2352x1568
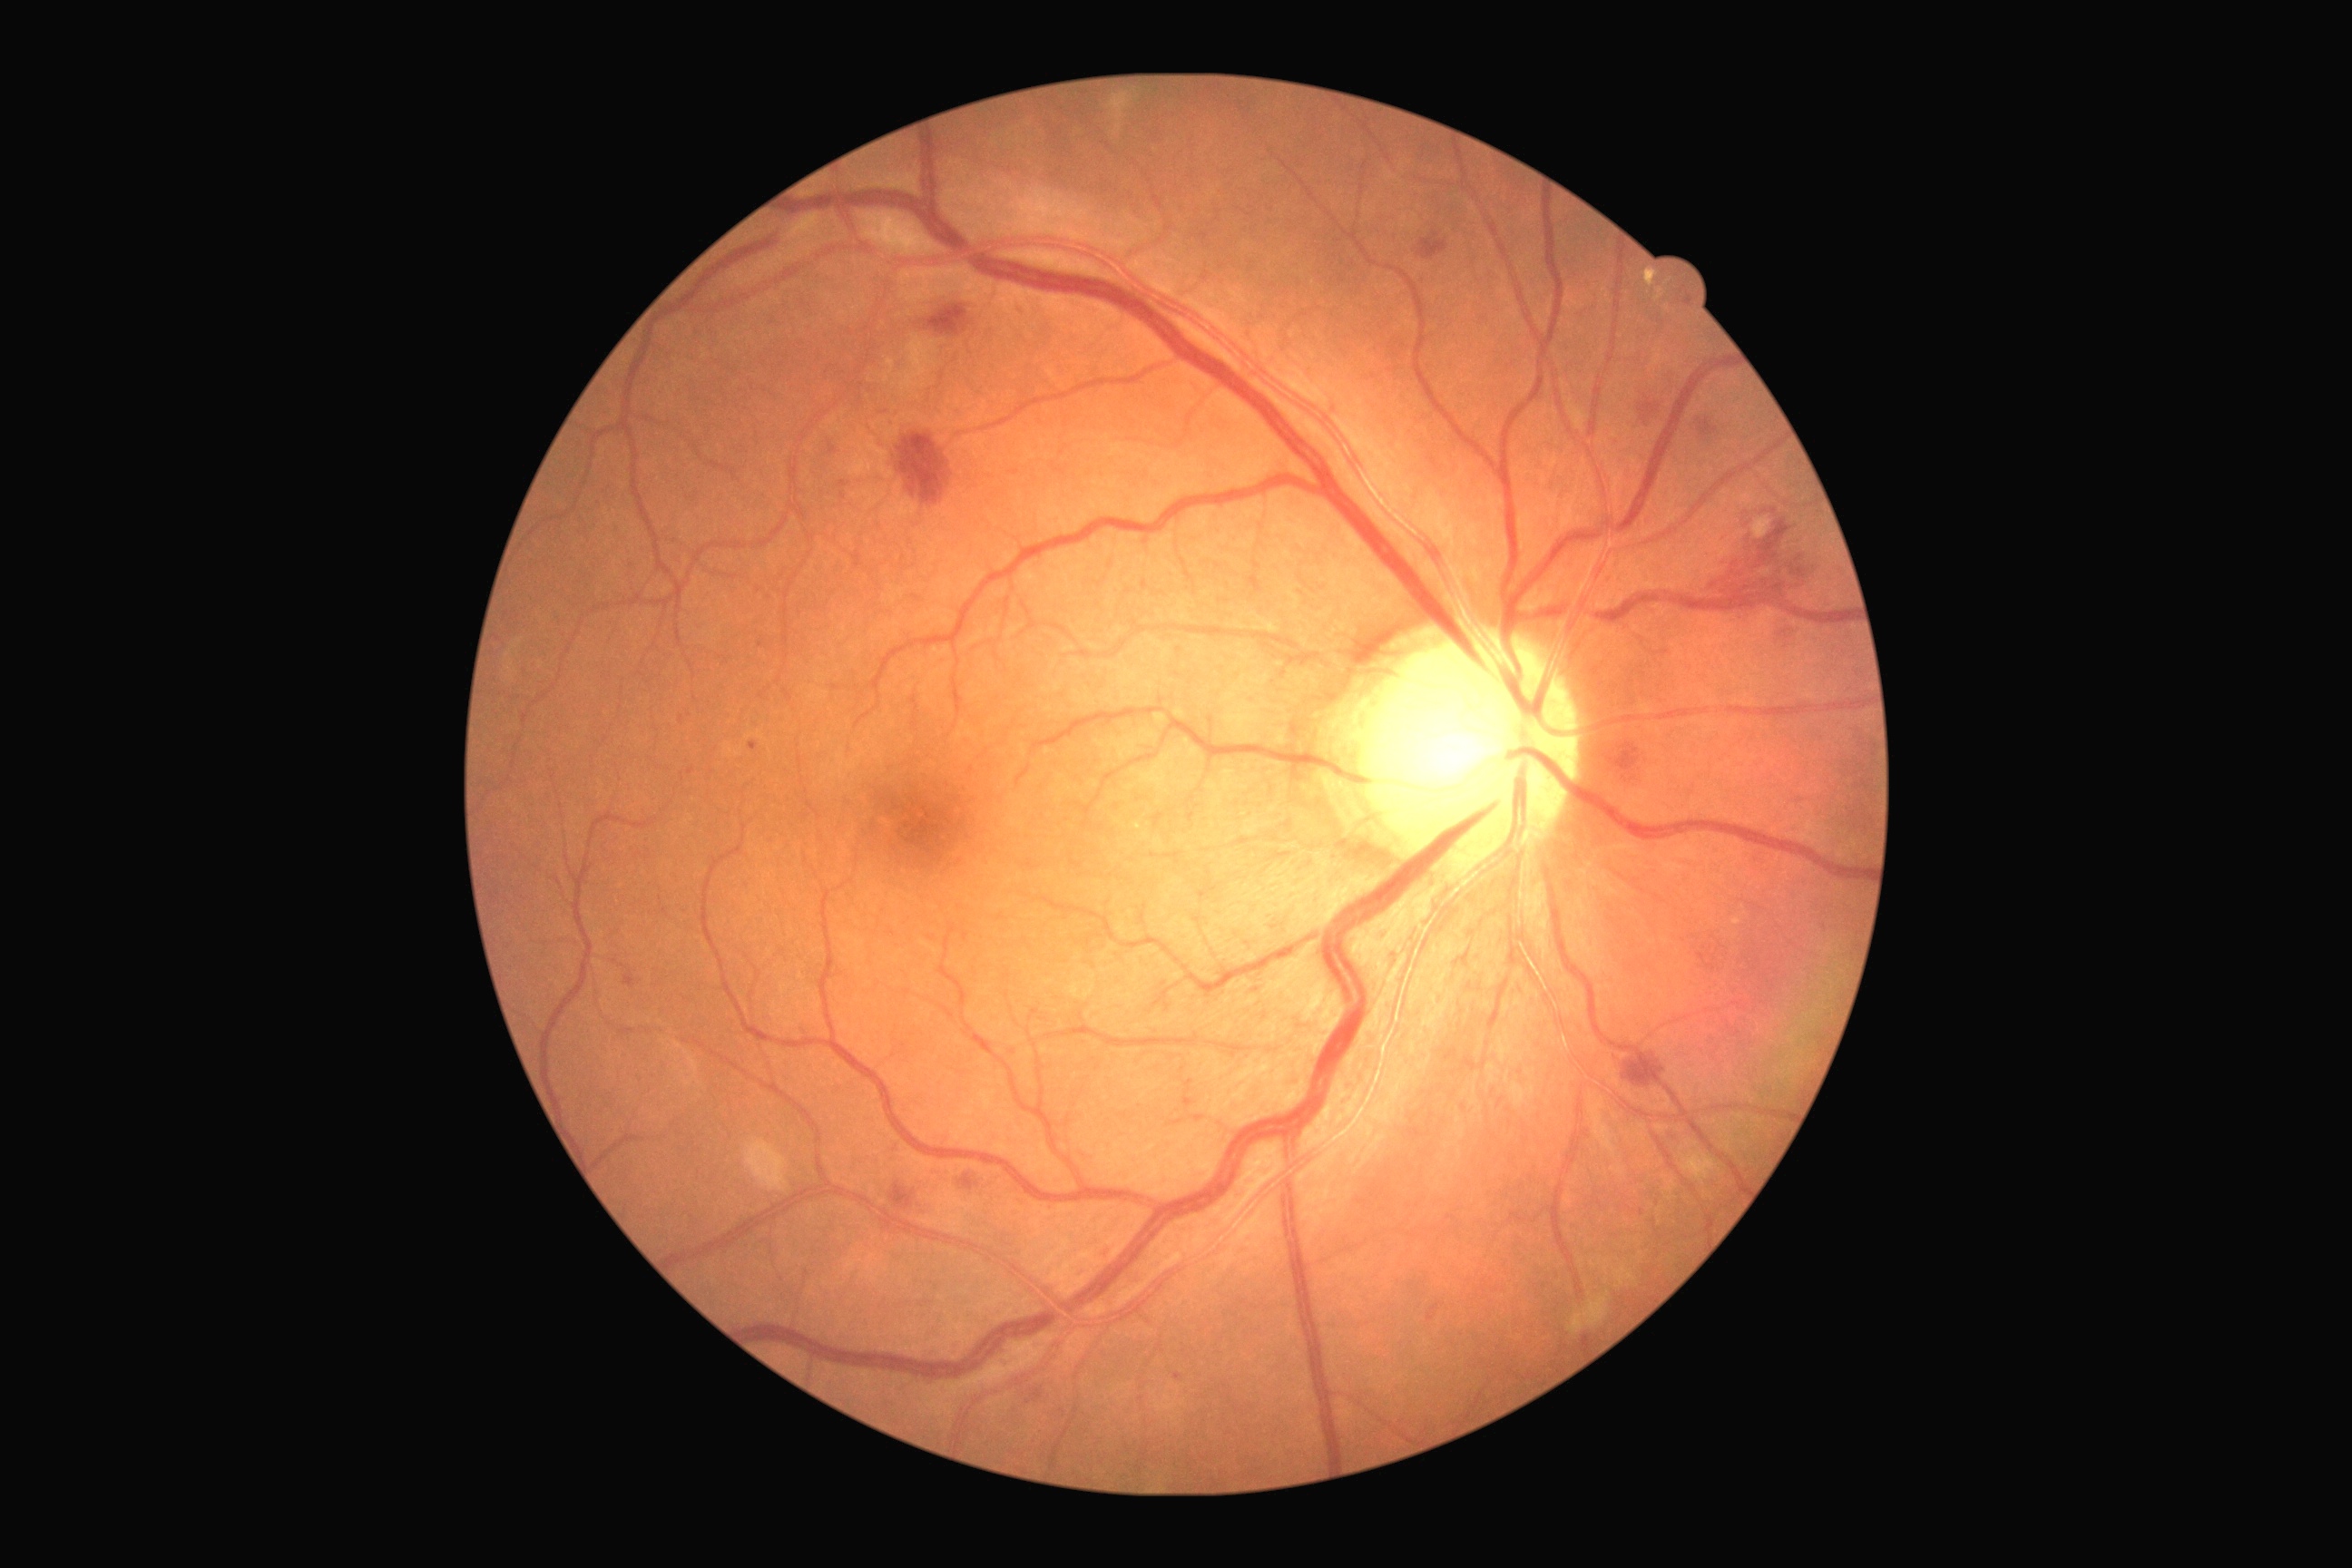 {
  "dr_grade": "2"
}